Color fundus photograph; 45° FOV; modified Davis grading.
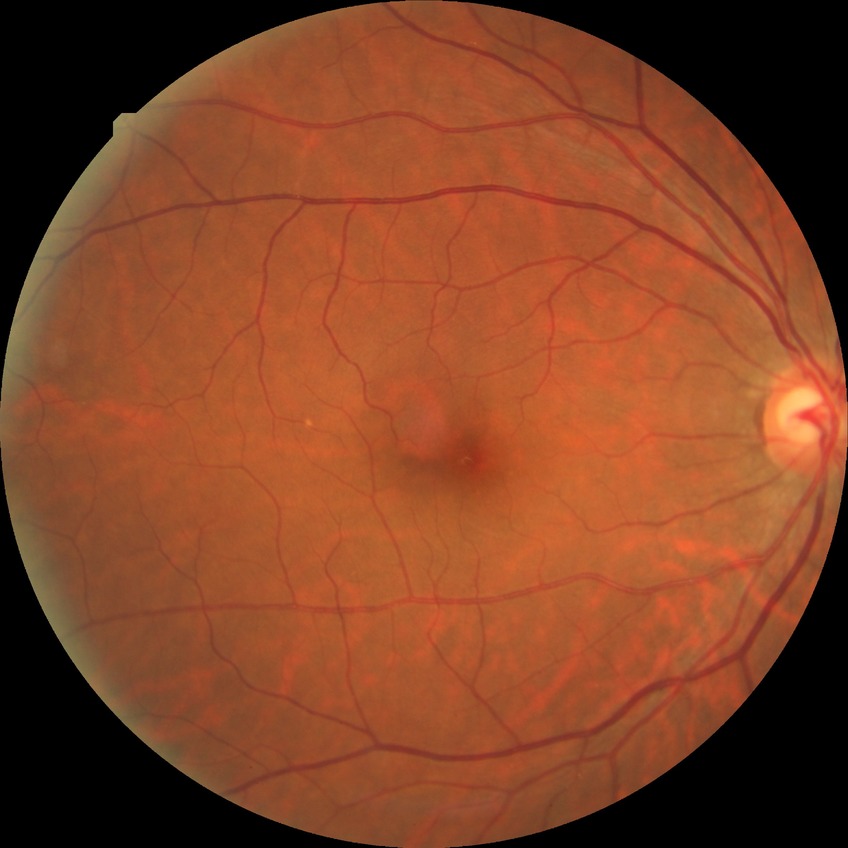
Diabetic retinopathy (DR) is NDR (no diabetic retinopathy).